45-degree field of view
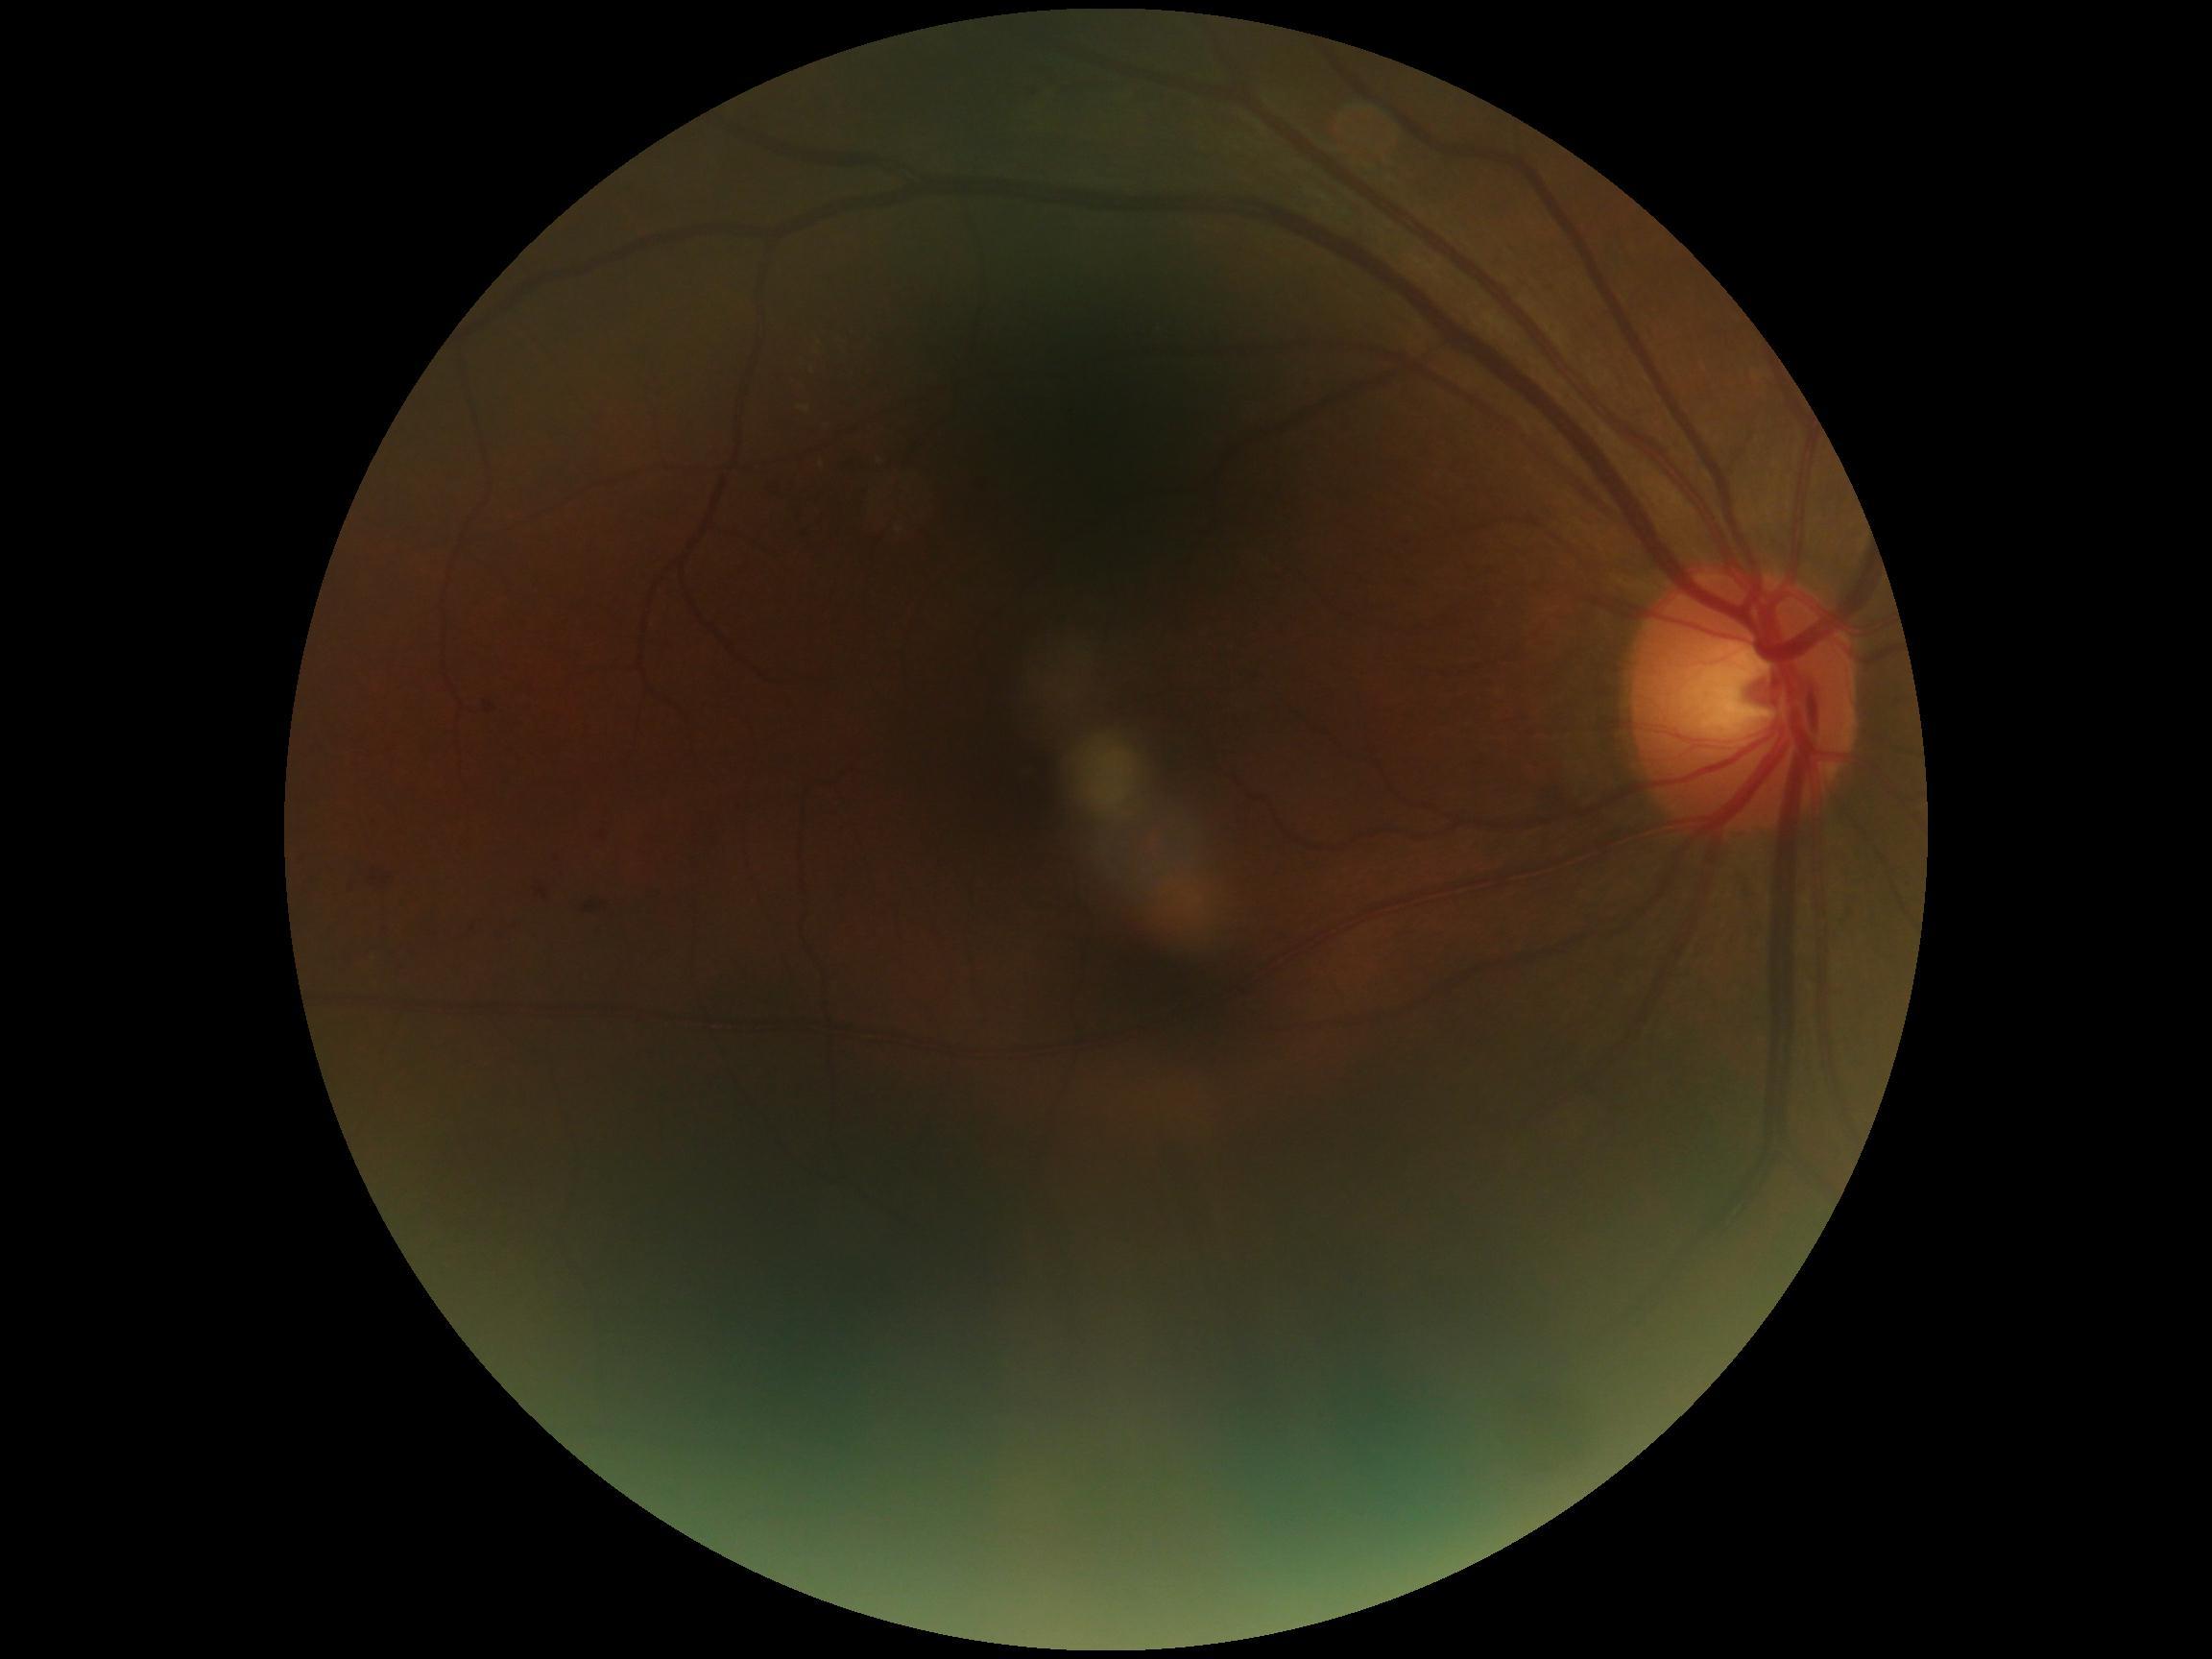

DR grade: 2.